45° field of view, fundus photo
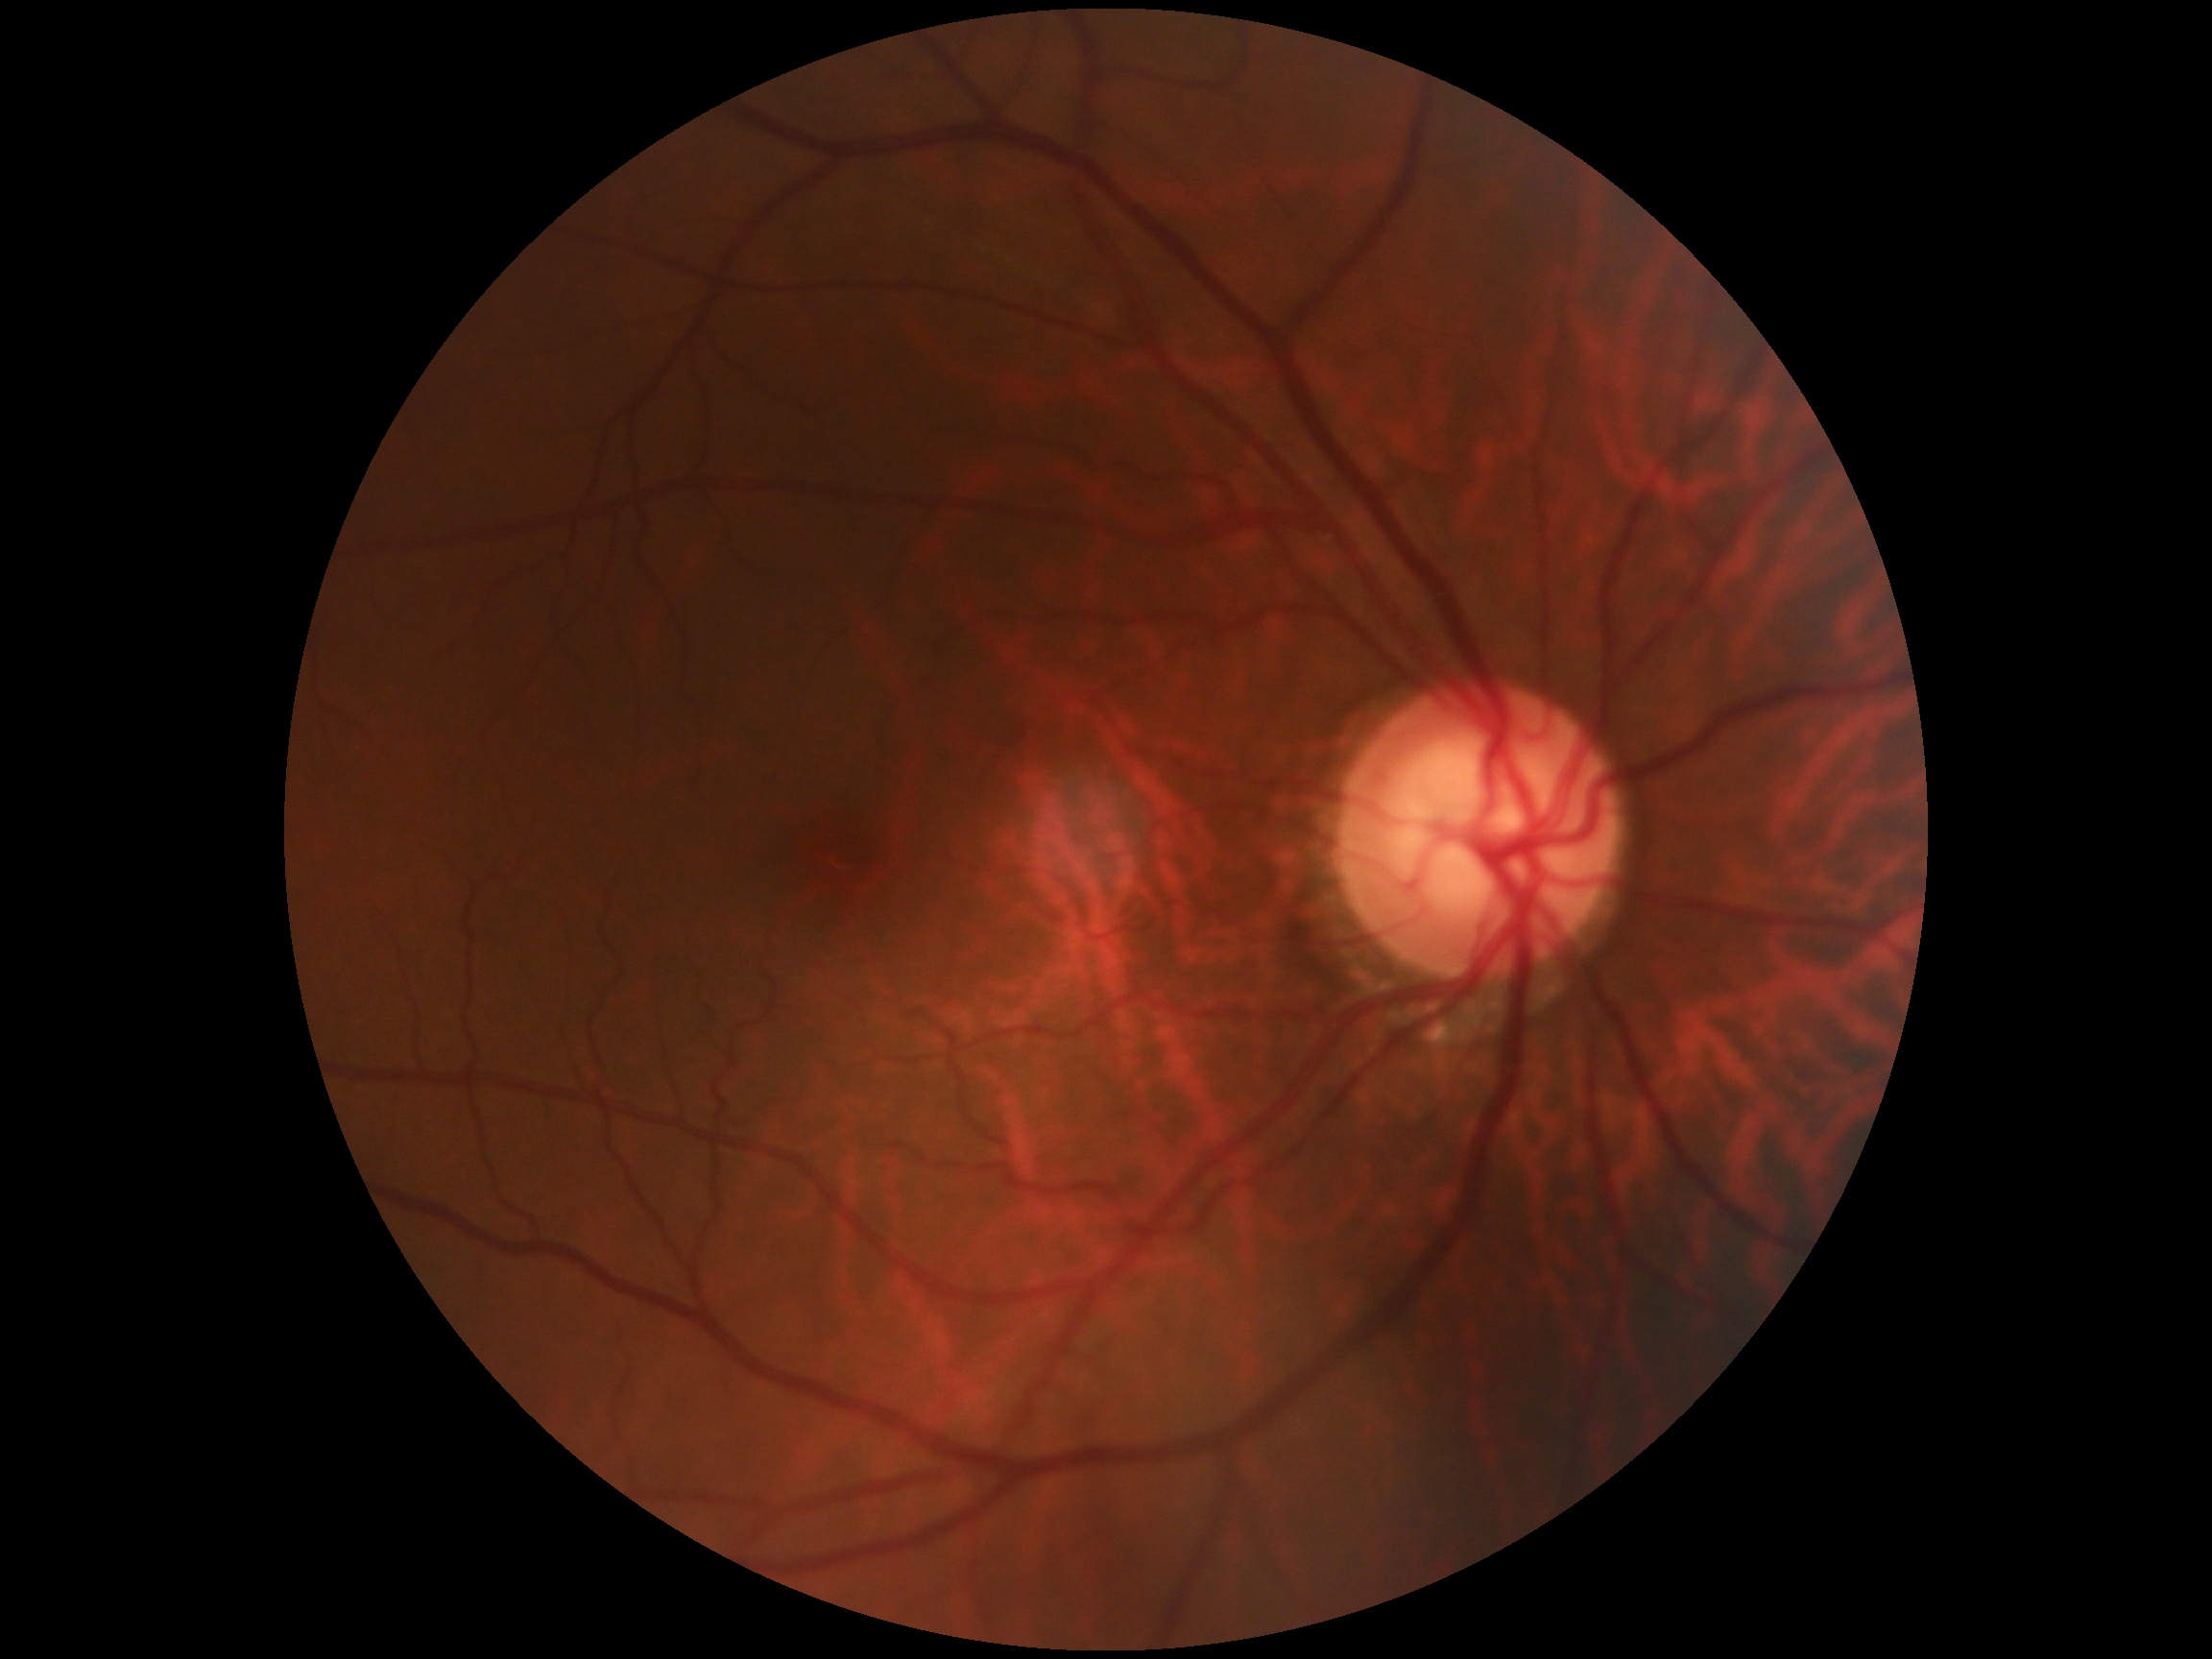
Annotations:
• DR stage: grade 0 (no apparent retinopathy)